Modified Davis classification, FOV: 45 degrees:
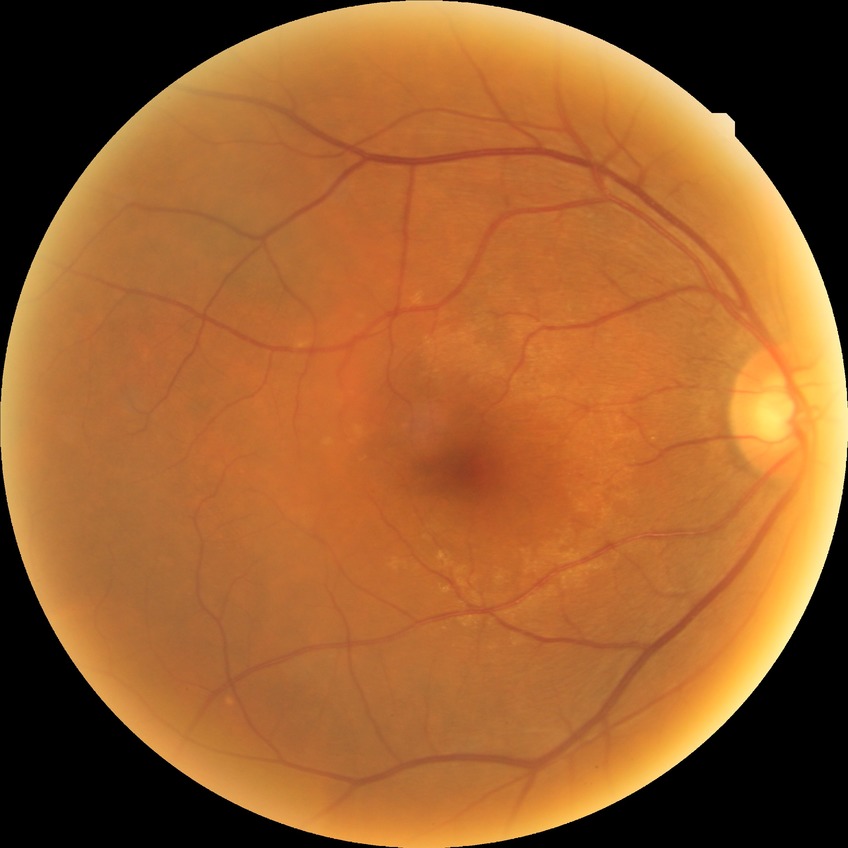

Diabetic retinopathy (DR): NDR (no diabetic retinopathy).